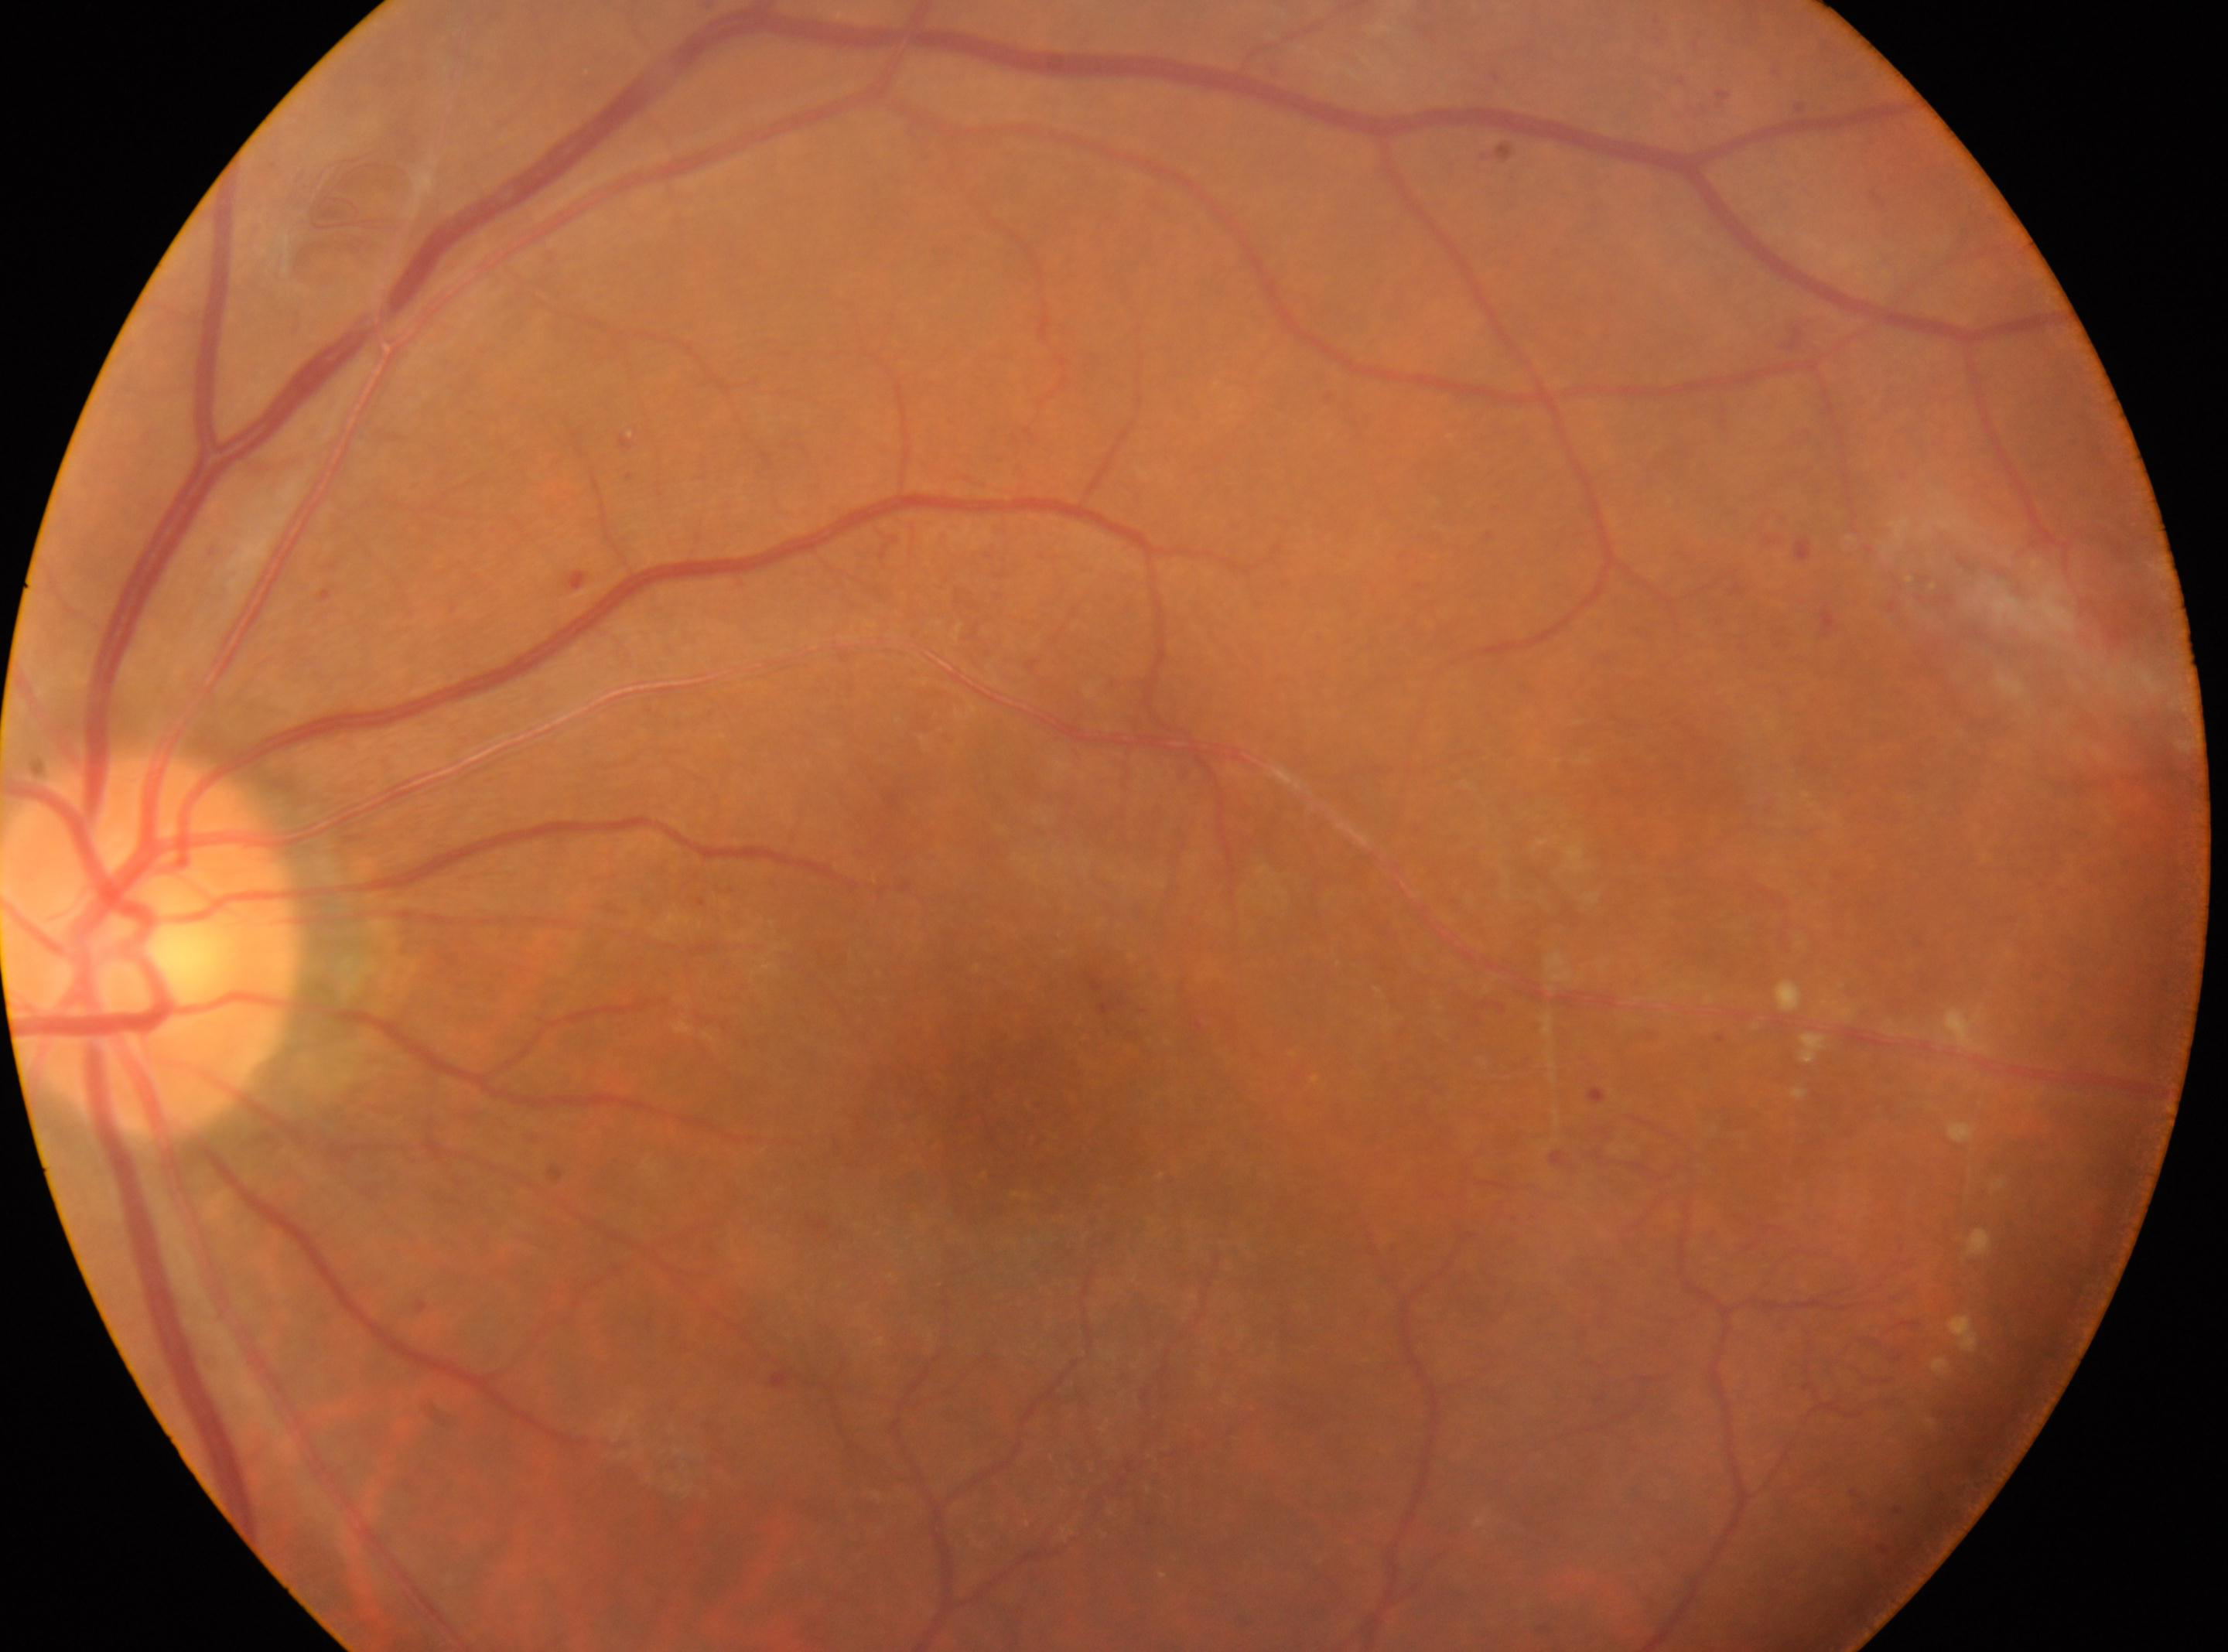 ONH = [152, 945]; laterality = left eye; macula center = [1021, 1112]; DR grade = 4 — neovascularization and/or vitreous/pre-retinal hemorrhage.